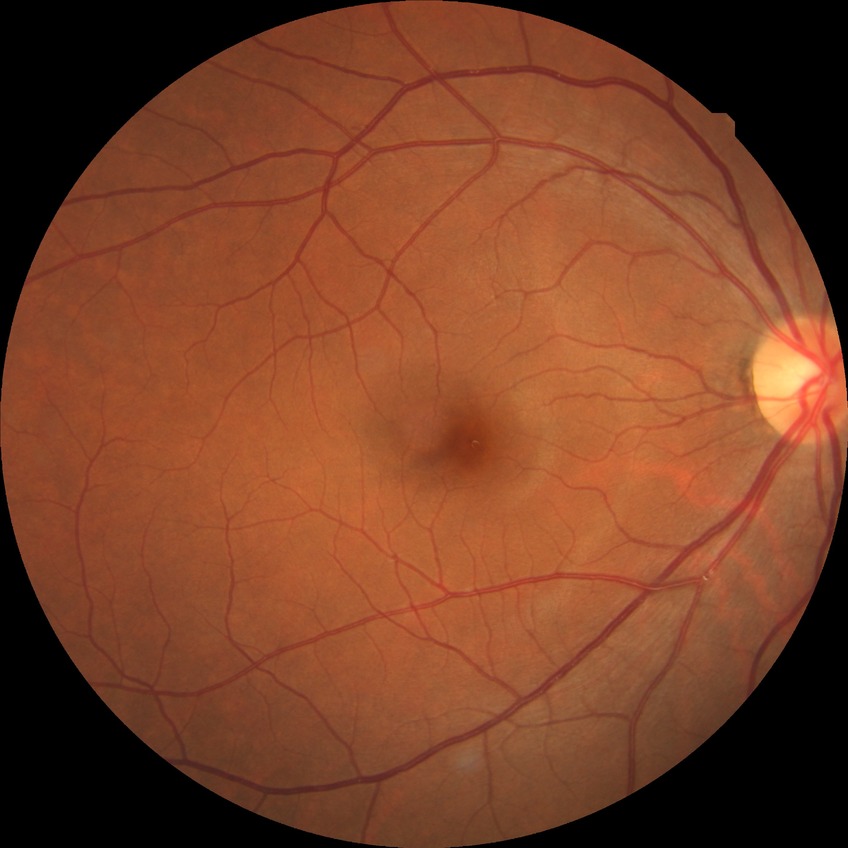
Diabetic retinopathy (DR): NDR (no diabetic retinopathy).